Wide-field fundus image from infant ROP screening. Captured with the Natus RetCam Envision (130° field of view).
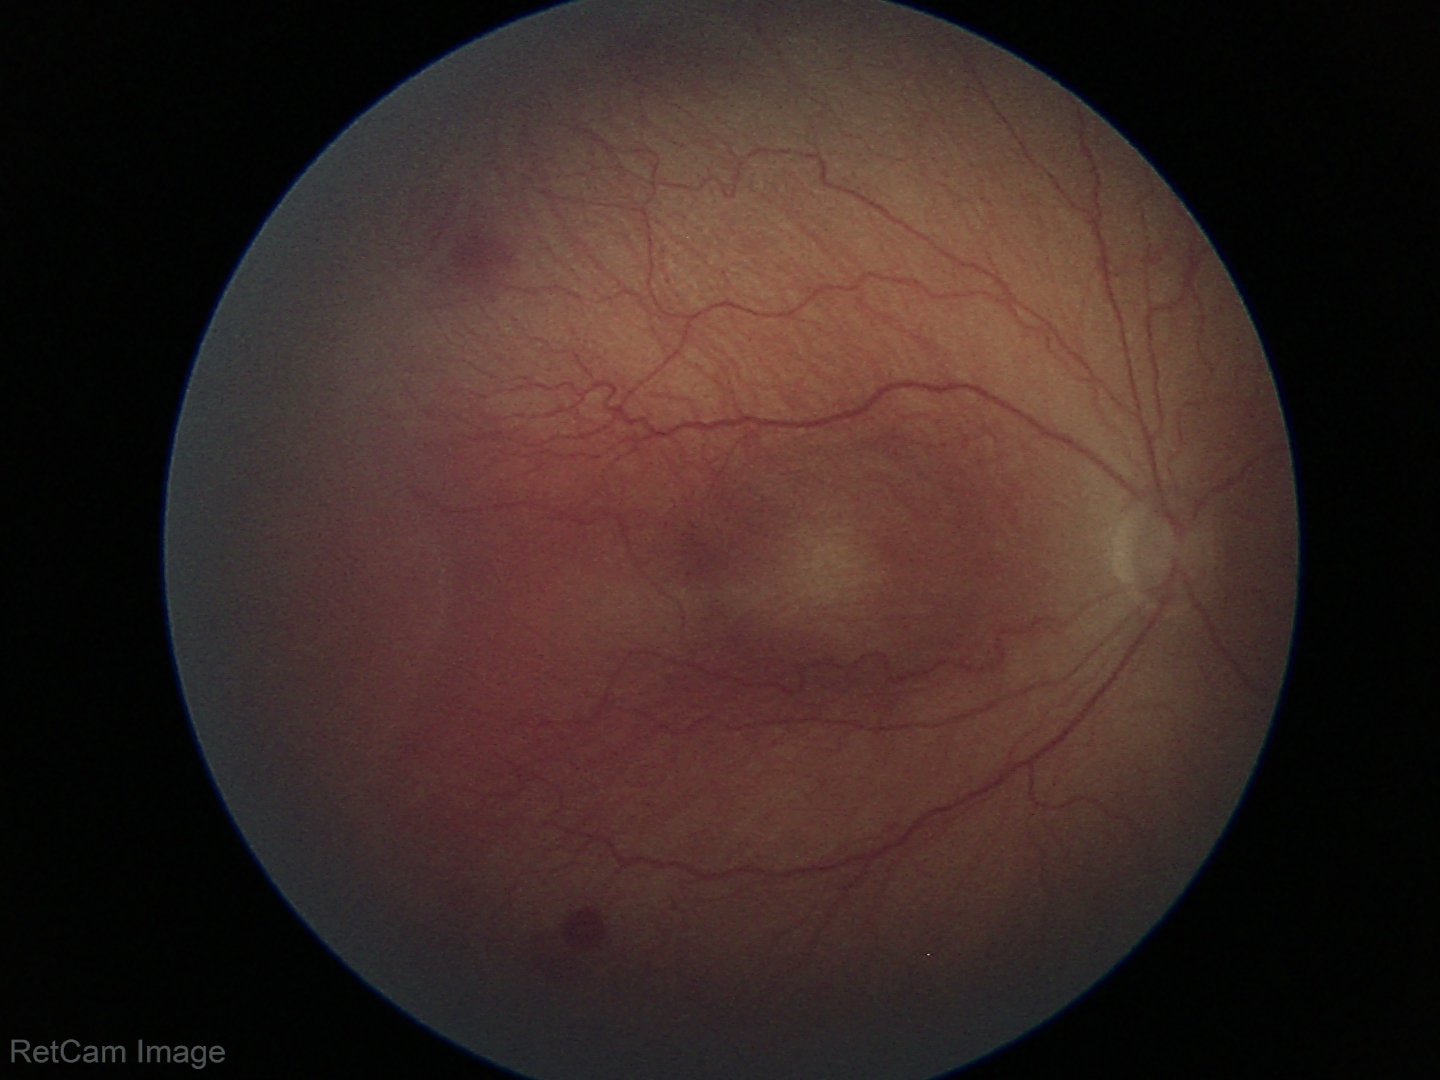

Assessment: retinopathy of prematurity stage 2; plus form: absent.